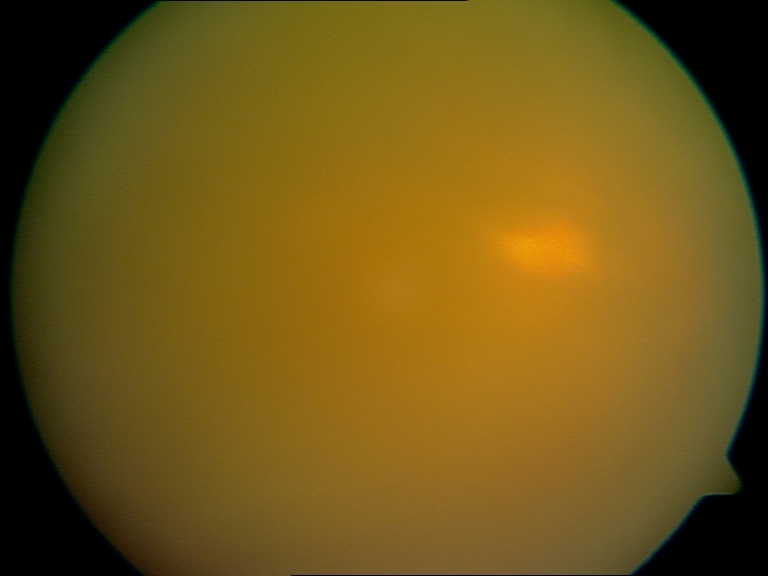 Poor-quality fundus photograph; retinal landmarks are largely obscured. Proliferative diabetic retinopathy not identified in the visible portion.